2352 x 1568 pixels:
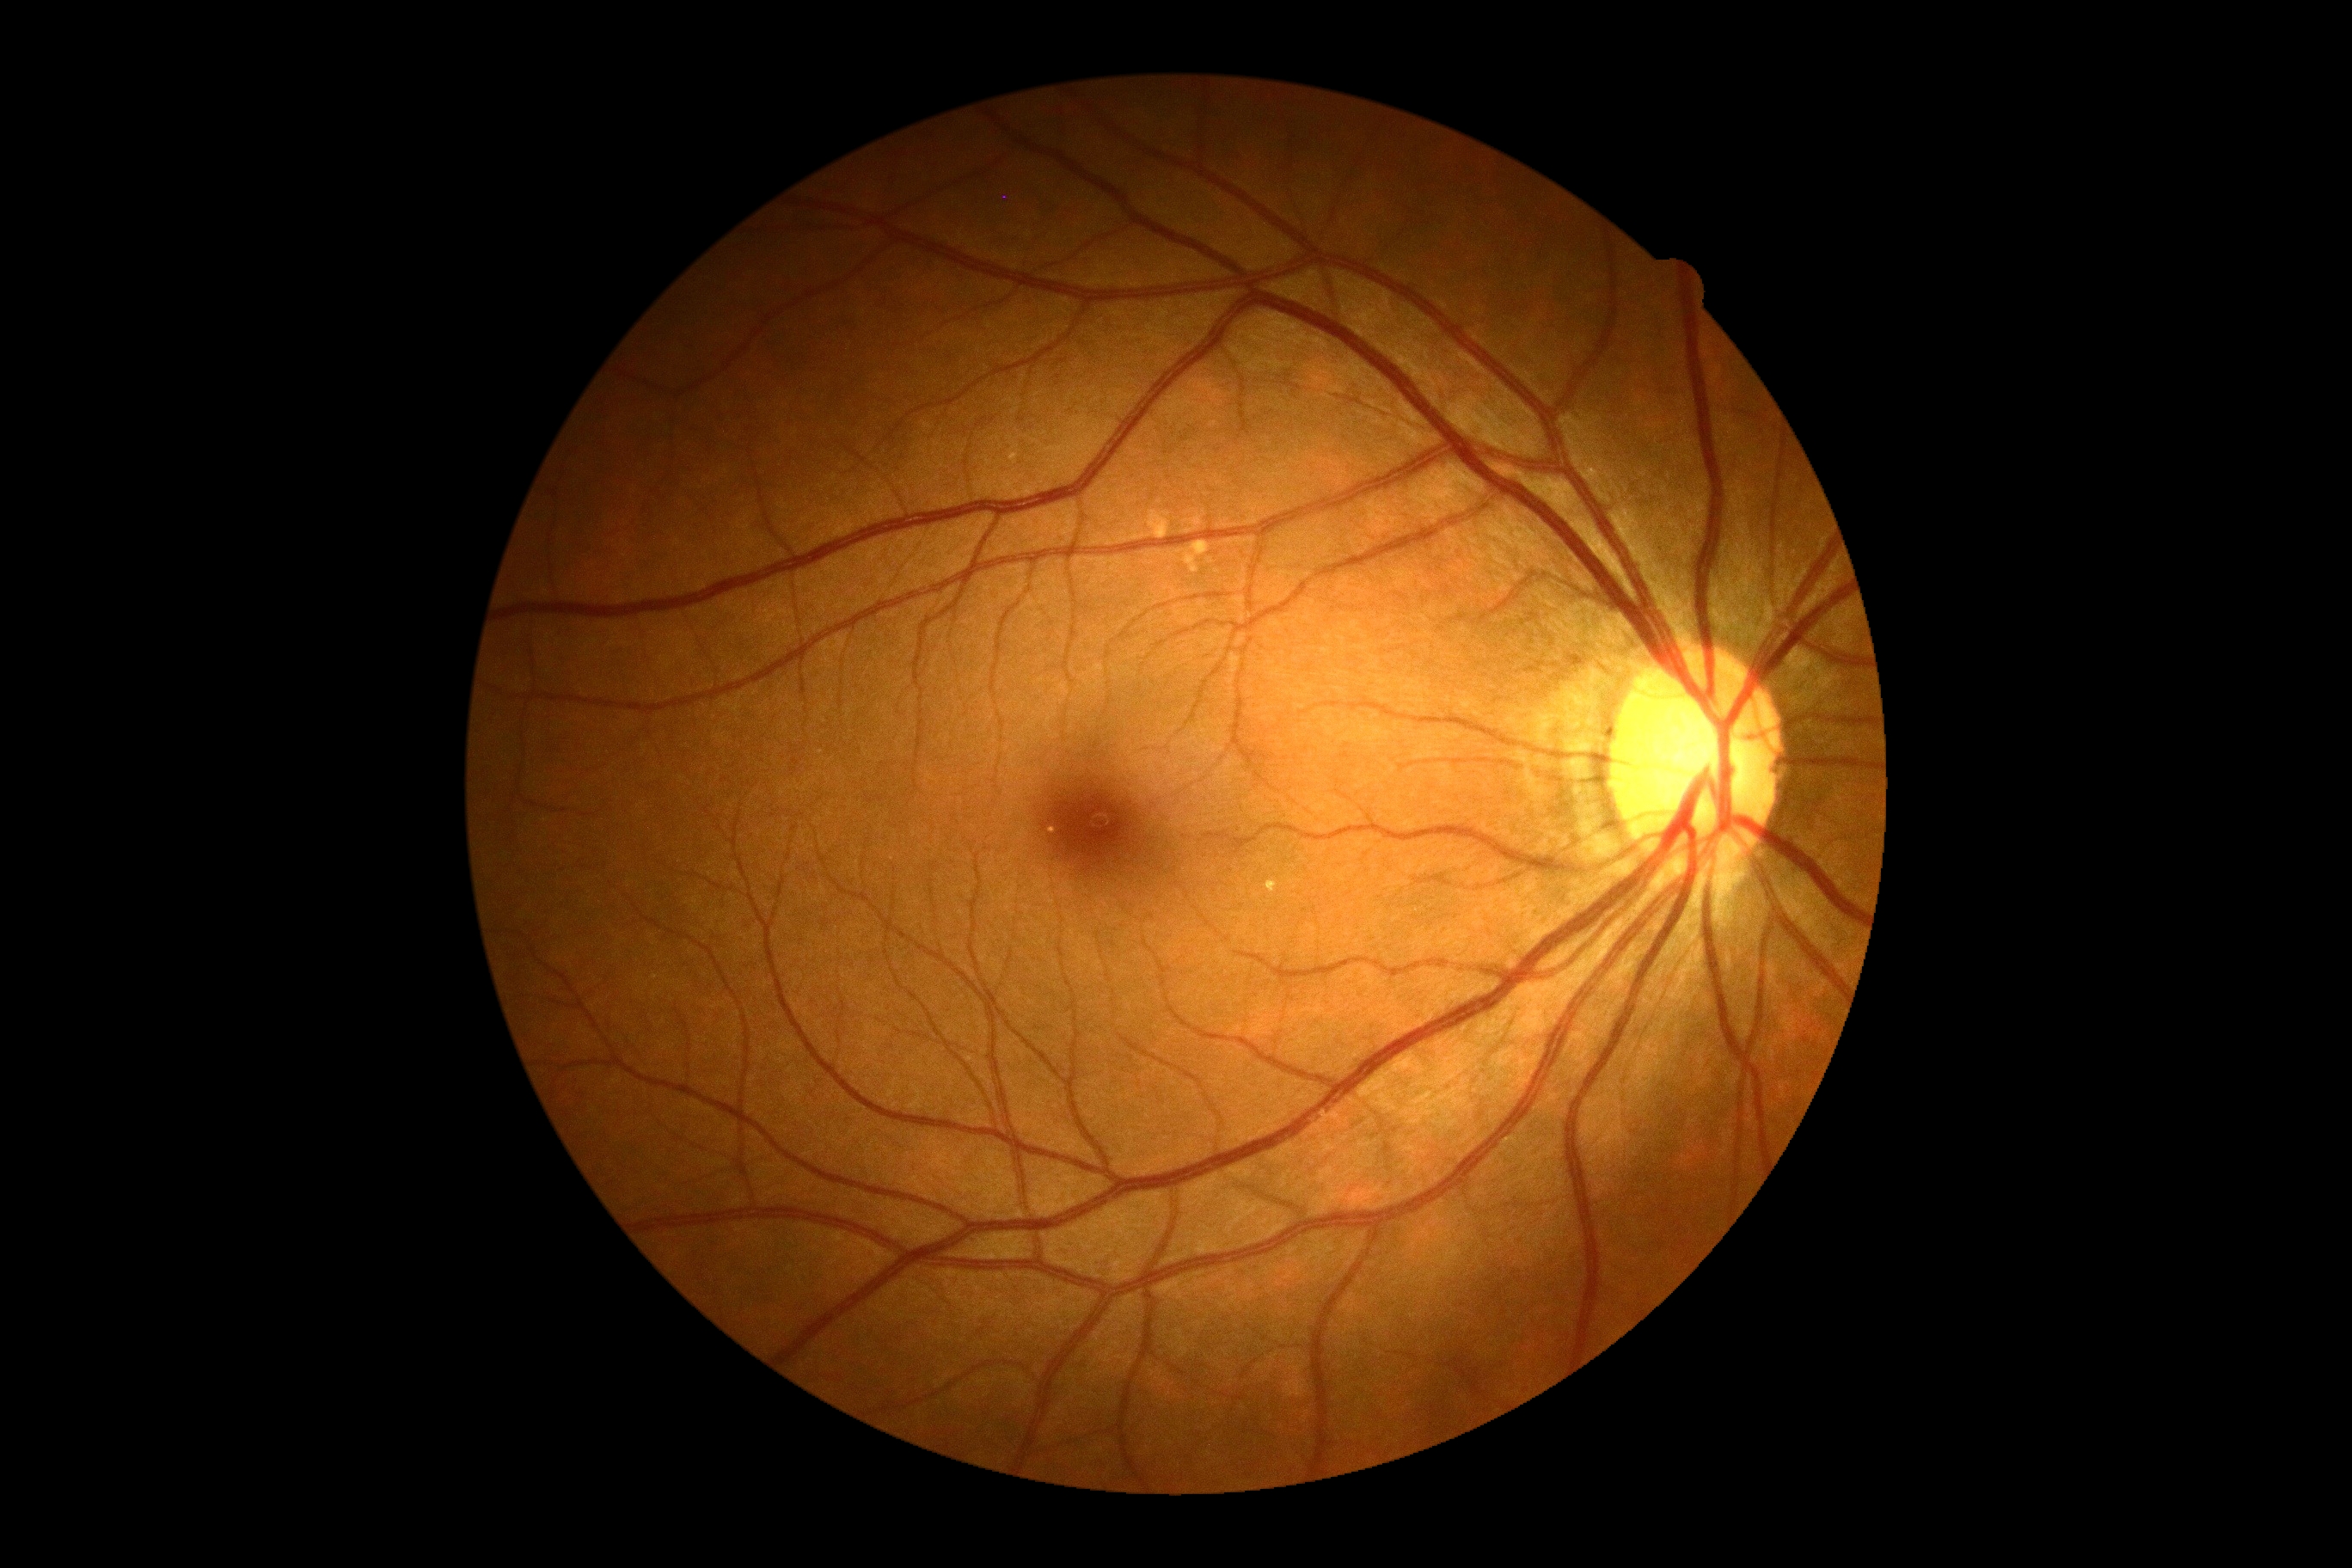 Findings:
* diabetic retinopathy — grade 0 (no apparent retinopathy)